Color fundus photograph. FOV: 45 degrees. 2346 x 1568 pixels.
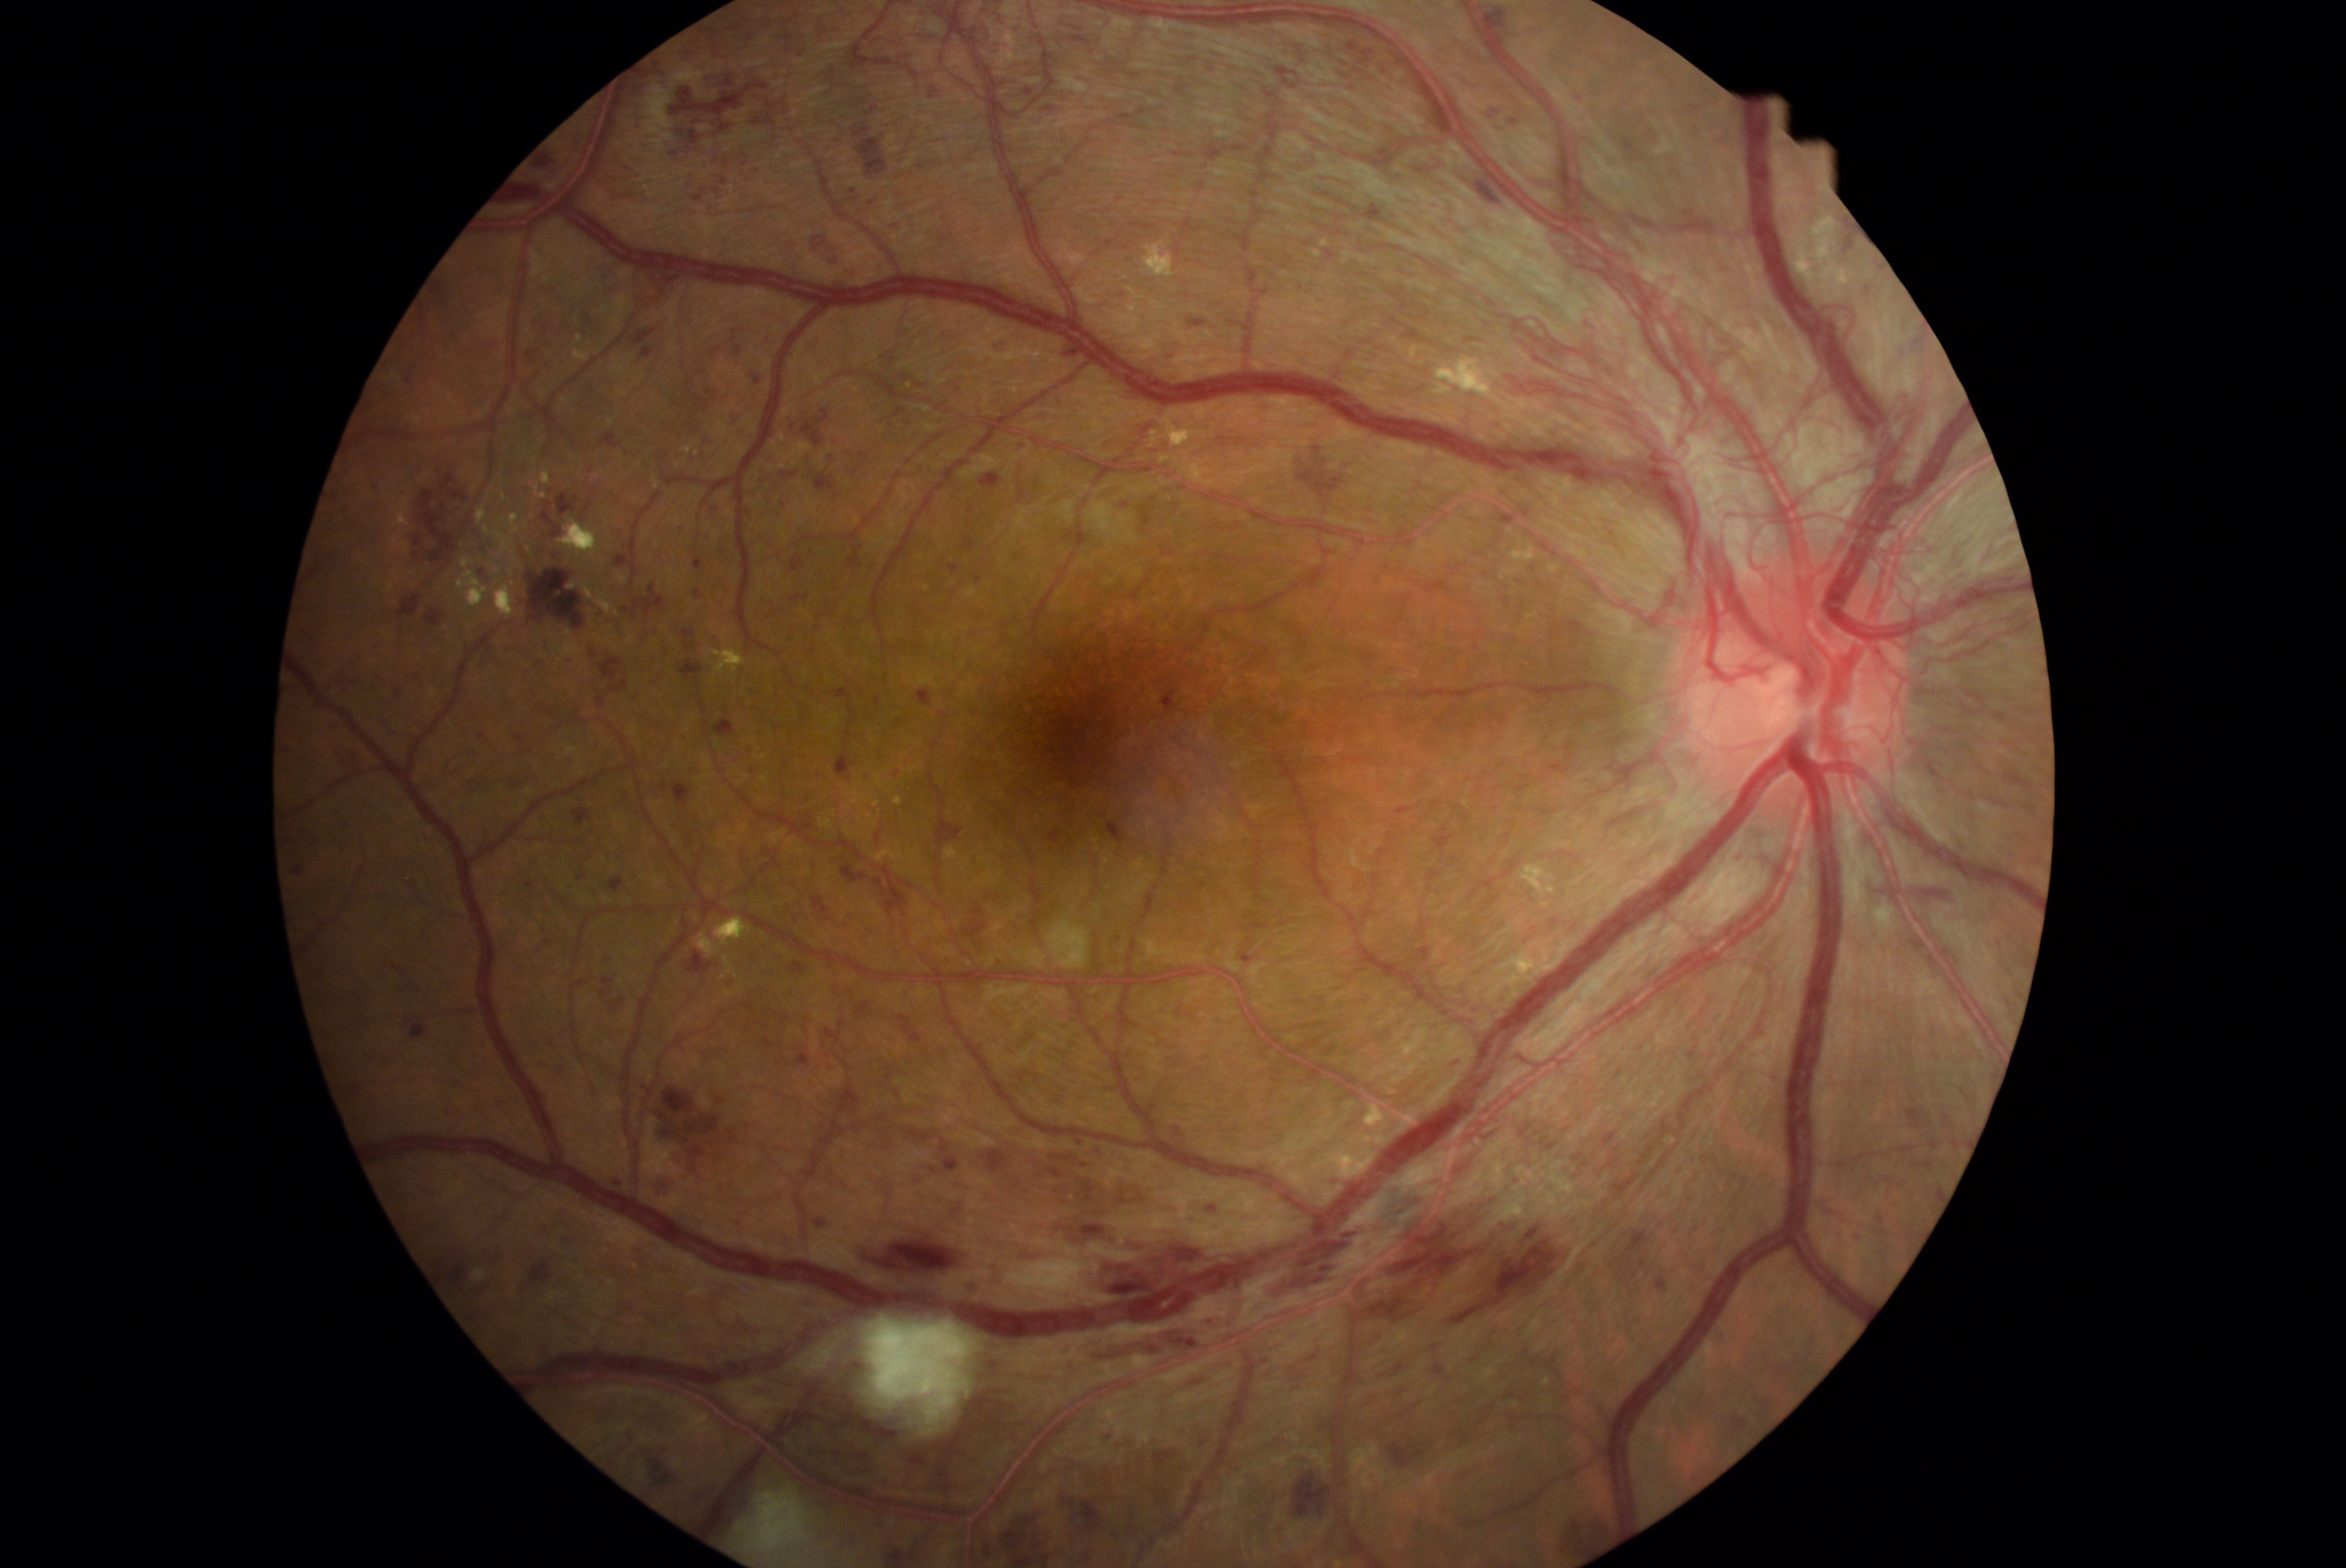 <lesions partial="true">
  <dr_grade>4</dr_grade>
  <he partial="true">[x1=961, y1=899, x2=989, y2=942]; [x1=573, y1=808, x2=594, y2=827]; [x1=1384, y1=1428, x2=1439, y2=1468]; [x1=835, y1=678, x2=854, y2=703]; [x1=1150, y1=1445, x2=1178, y2=1473]; [x1=855, y1=206, x2=863, y2=216]; [x1=299, y1=755, x2=313, y2=763]; [x1=779, y1=29, x2=796, y2=42]; [x1=1349, y1=43, x2=1376, y2=65]; [x1=443, y1=1106, x2=454, y2=1119]; [x1=1912, y1=937, x2=1928, y2=953]; [x1=1175, y1=1127, x2=1180, y2=1138]; [x1=1497, y1=510, x2=1516, y2=526]; [x1=1290, y1=440, x2=1349, y2=512]; [x1=512, y1=731, x2=532, y2=747]; [x1=1603, y1=1131, x2=1616, y2=1145]; [x1=730, y1=23, x2=743, y2=31]</he>
  <he_small>859, 106; 862, 691</he_small>
</lesions>